45-degree field of view; NIDEK AFC-230; fundus photo — 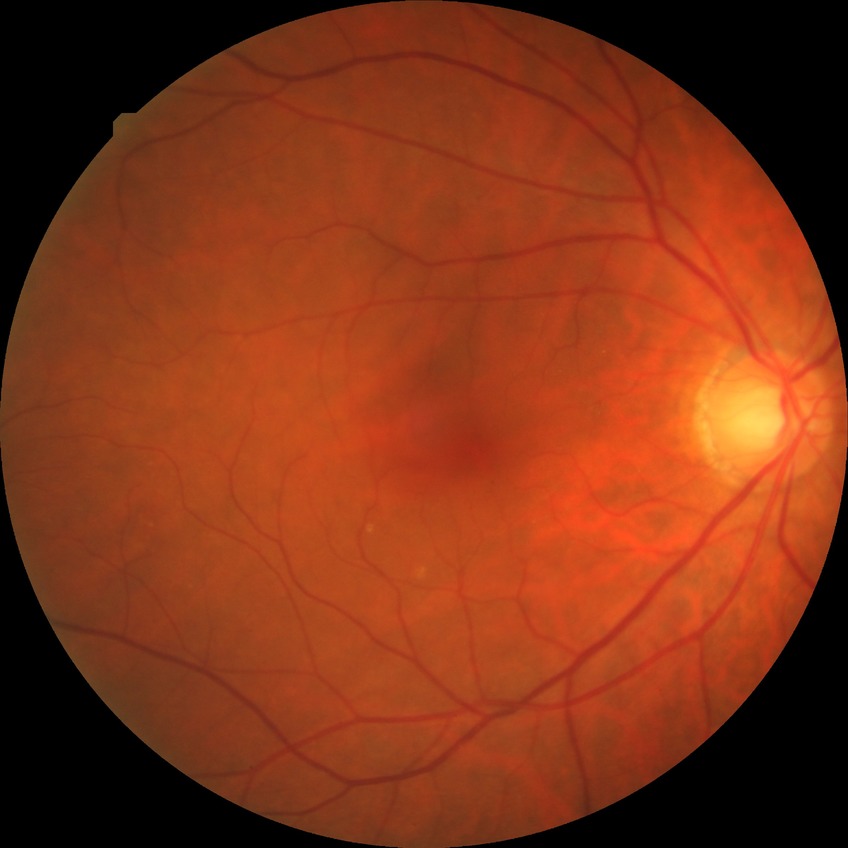
diabetic retinopathy (DR): no diabetic retinopathy (NDR).